Color fundus photograph · graded on the modified Davis scale · no pharmacologic dilation.
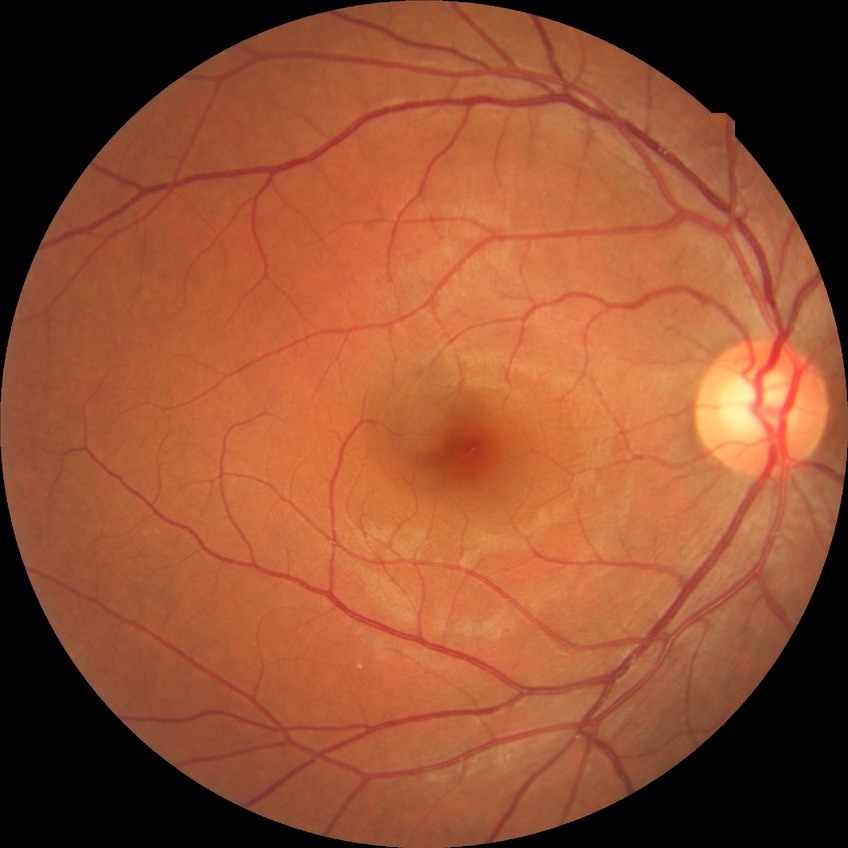 diabetic retinopathy stage = no diabetic retinopathy.